Optic disc at the center of the field; non-mydriatic acquisition; FOV: 30 degrees
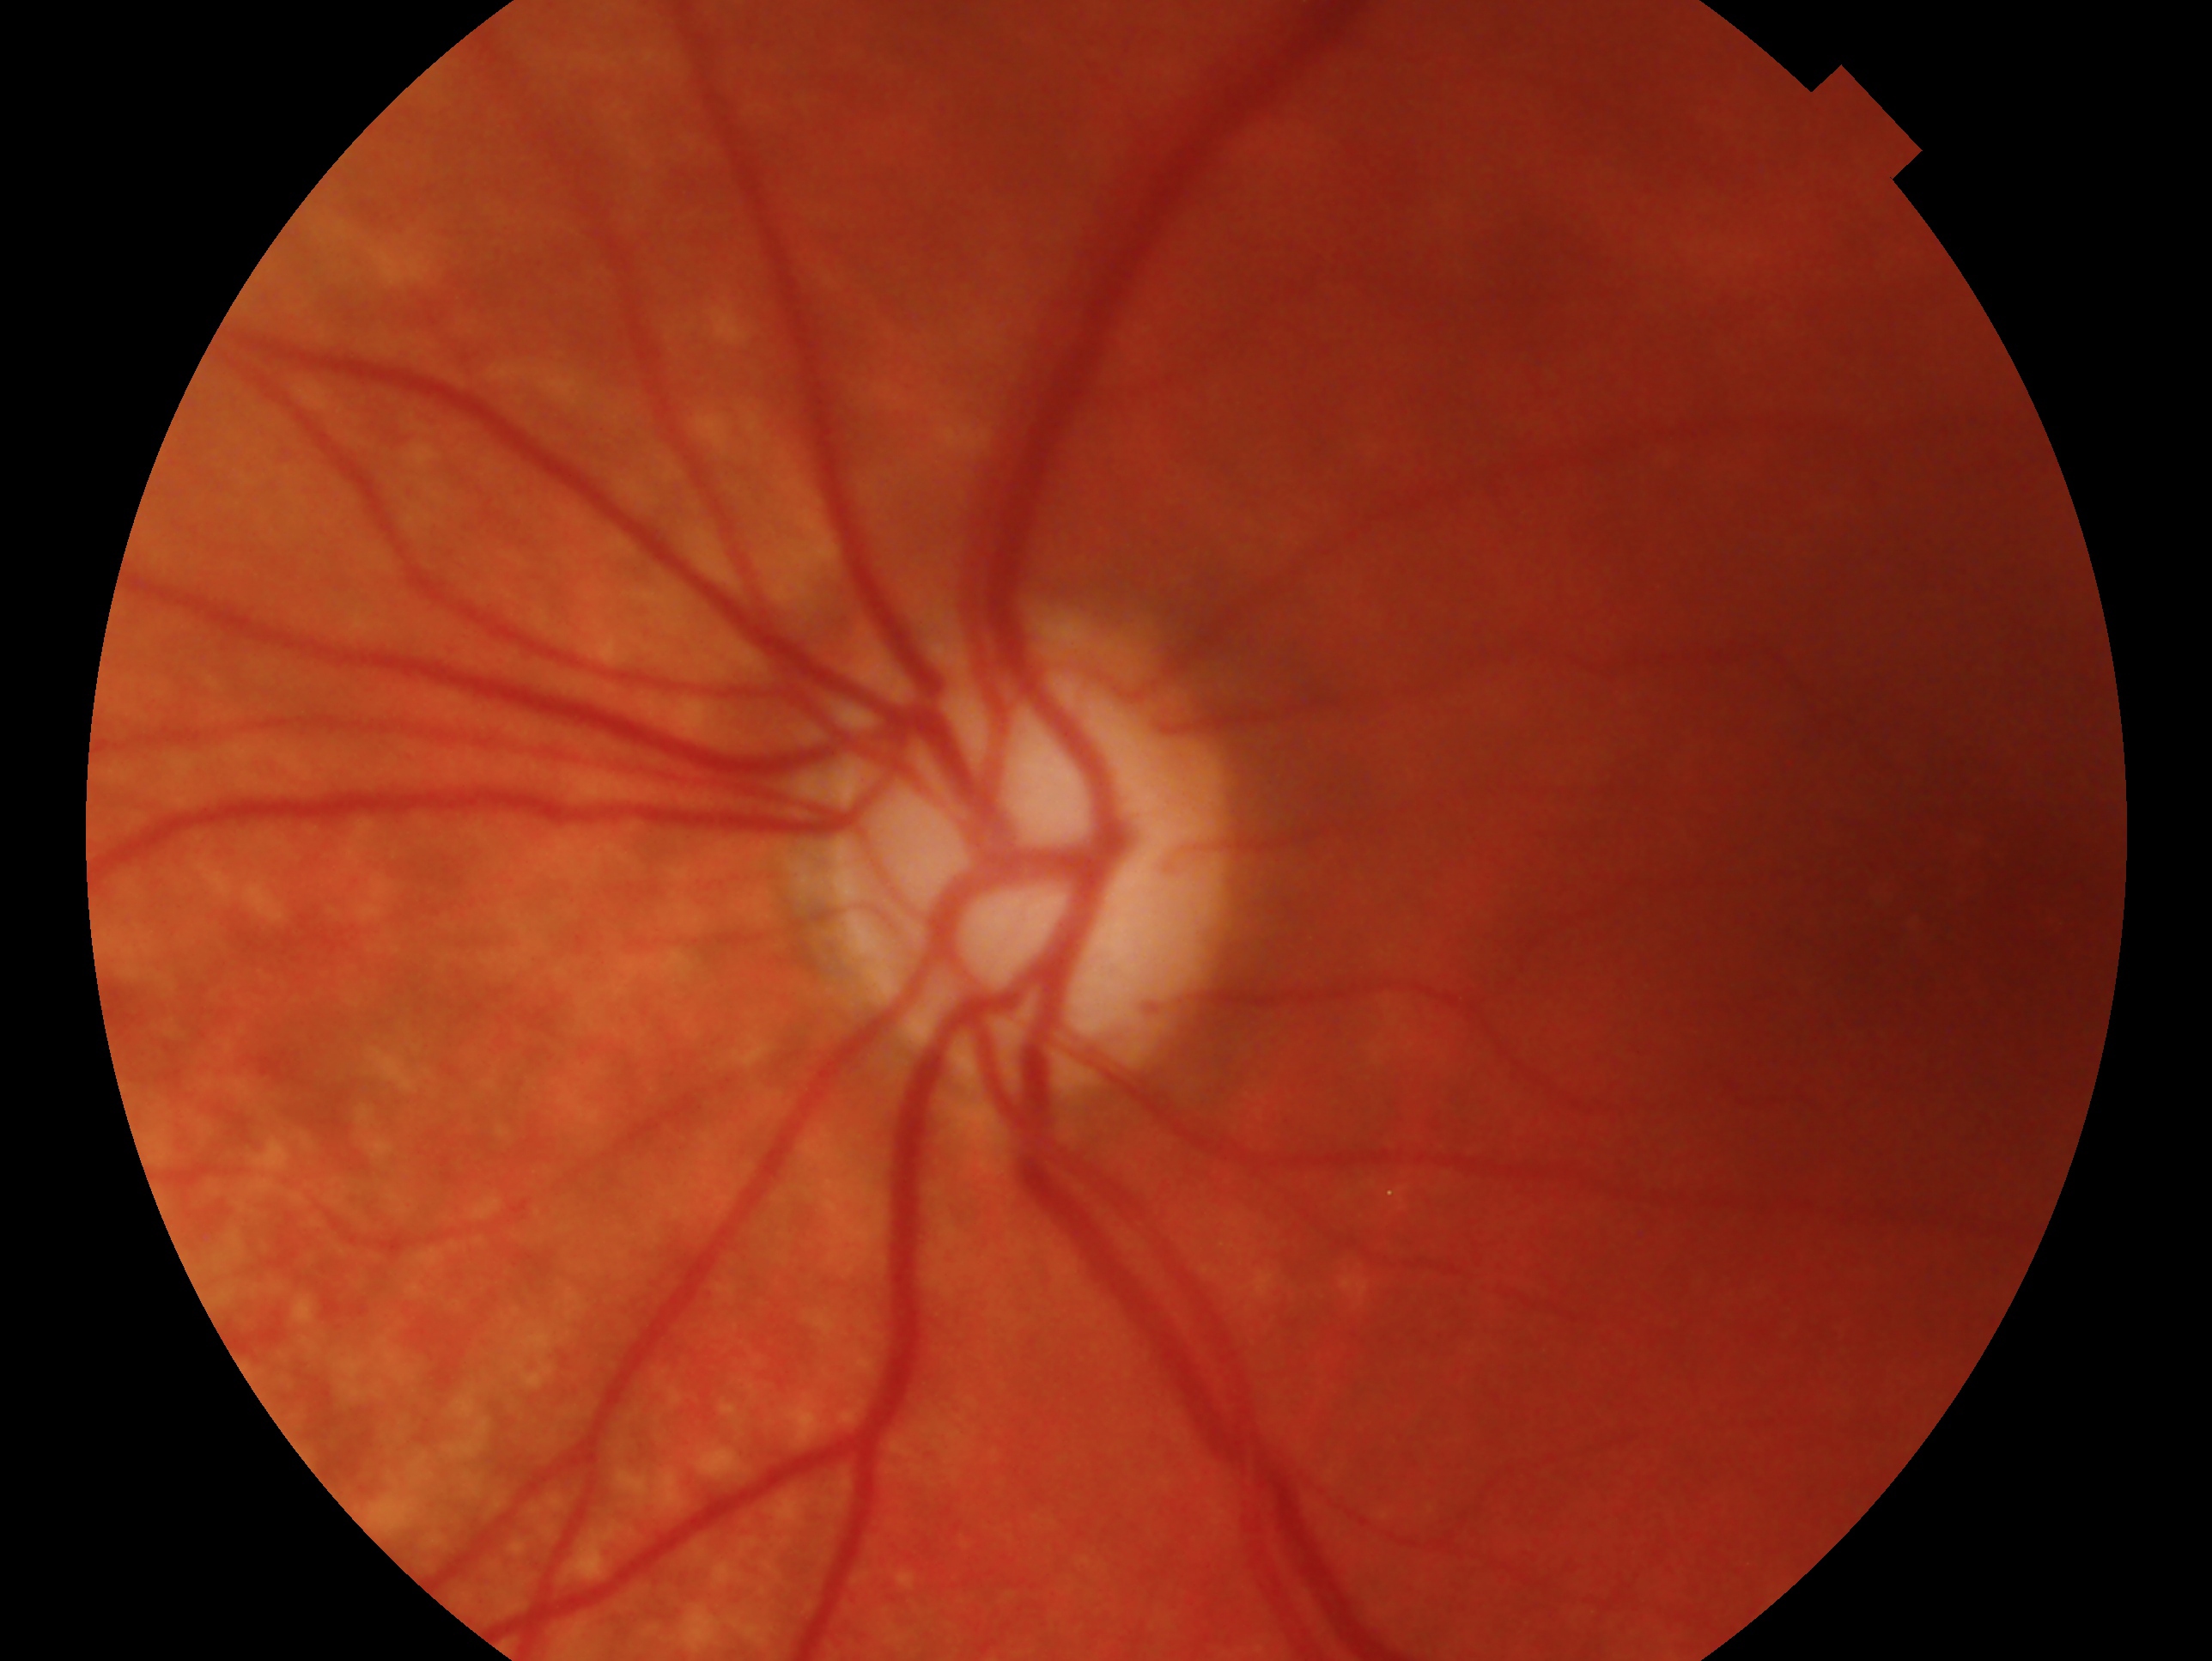
laterality: left eye, clinical classification: glaucomatous.